Image size 2352x1568.
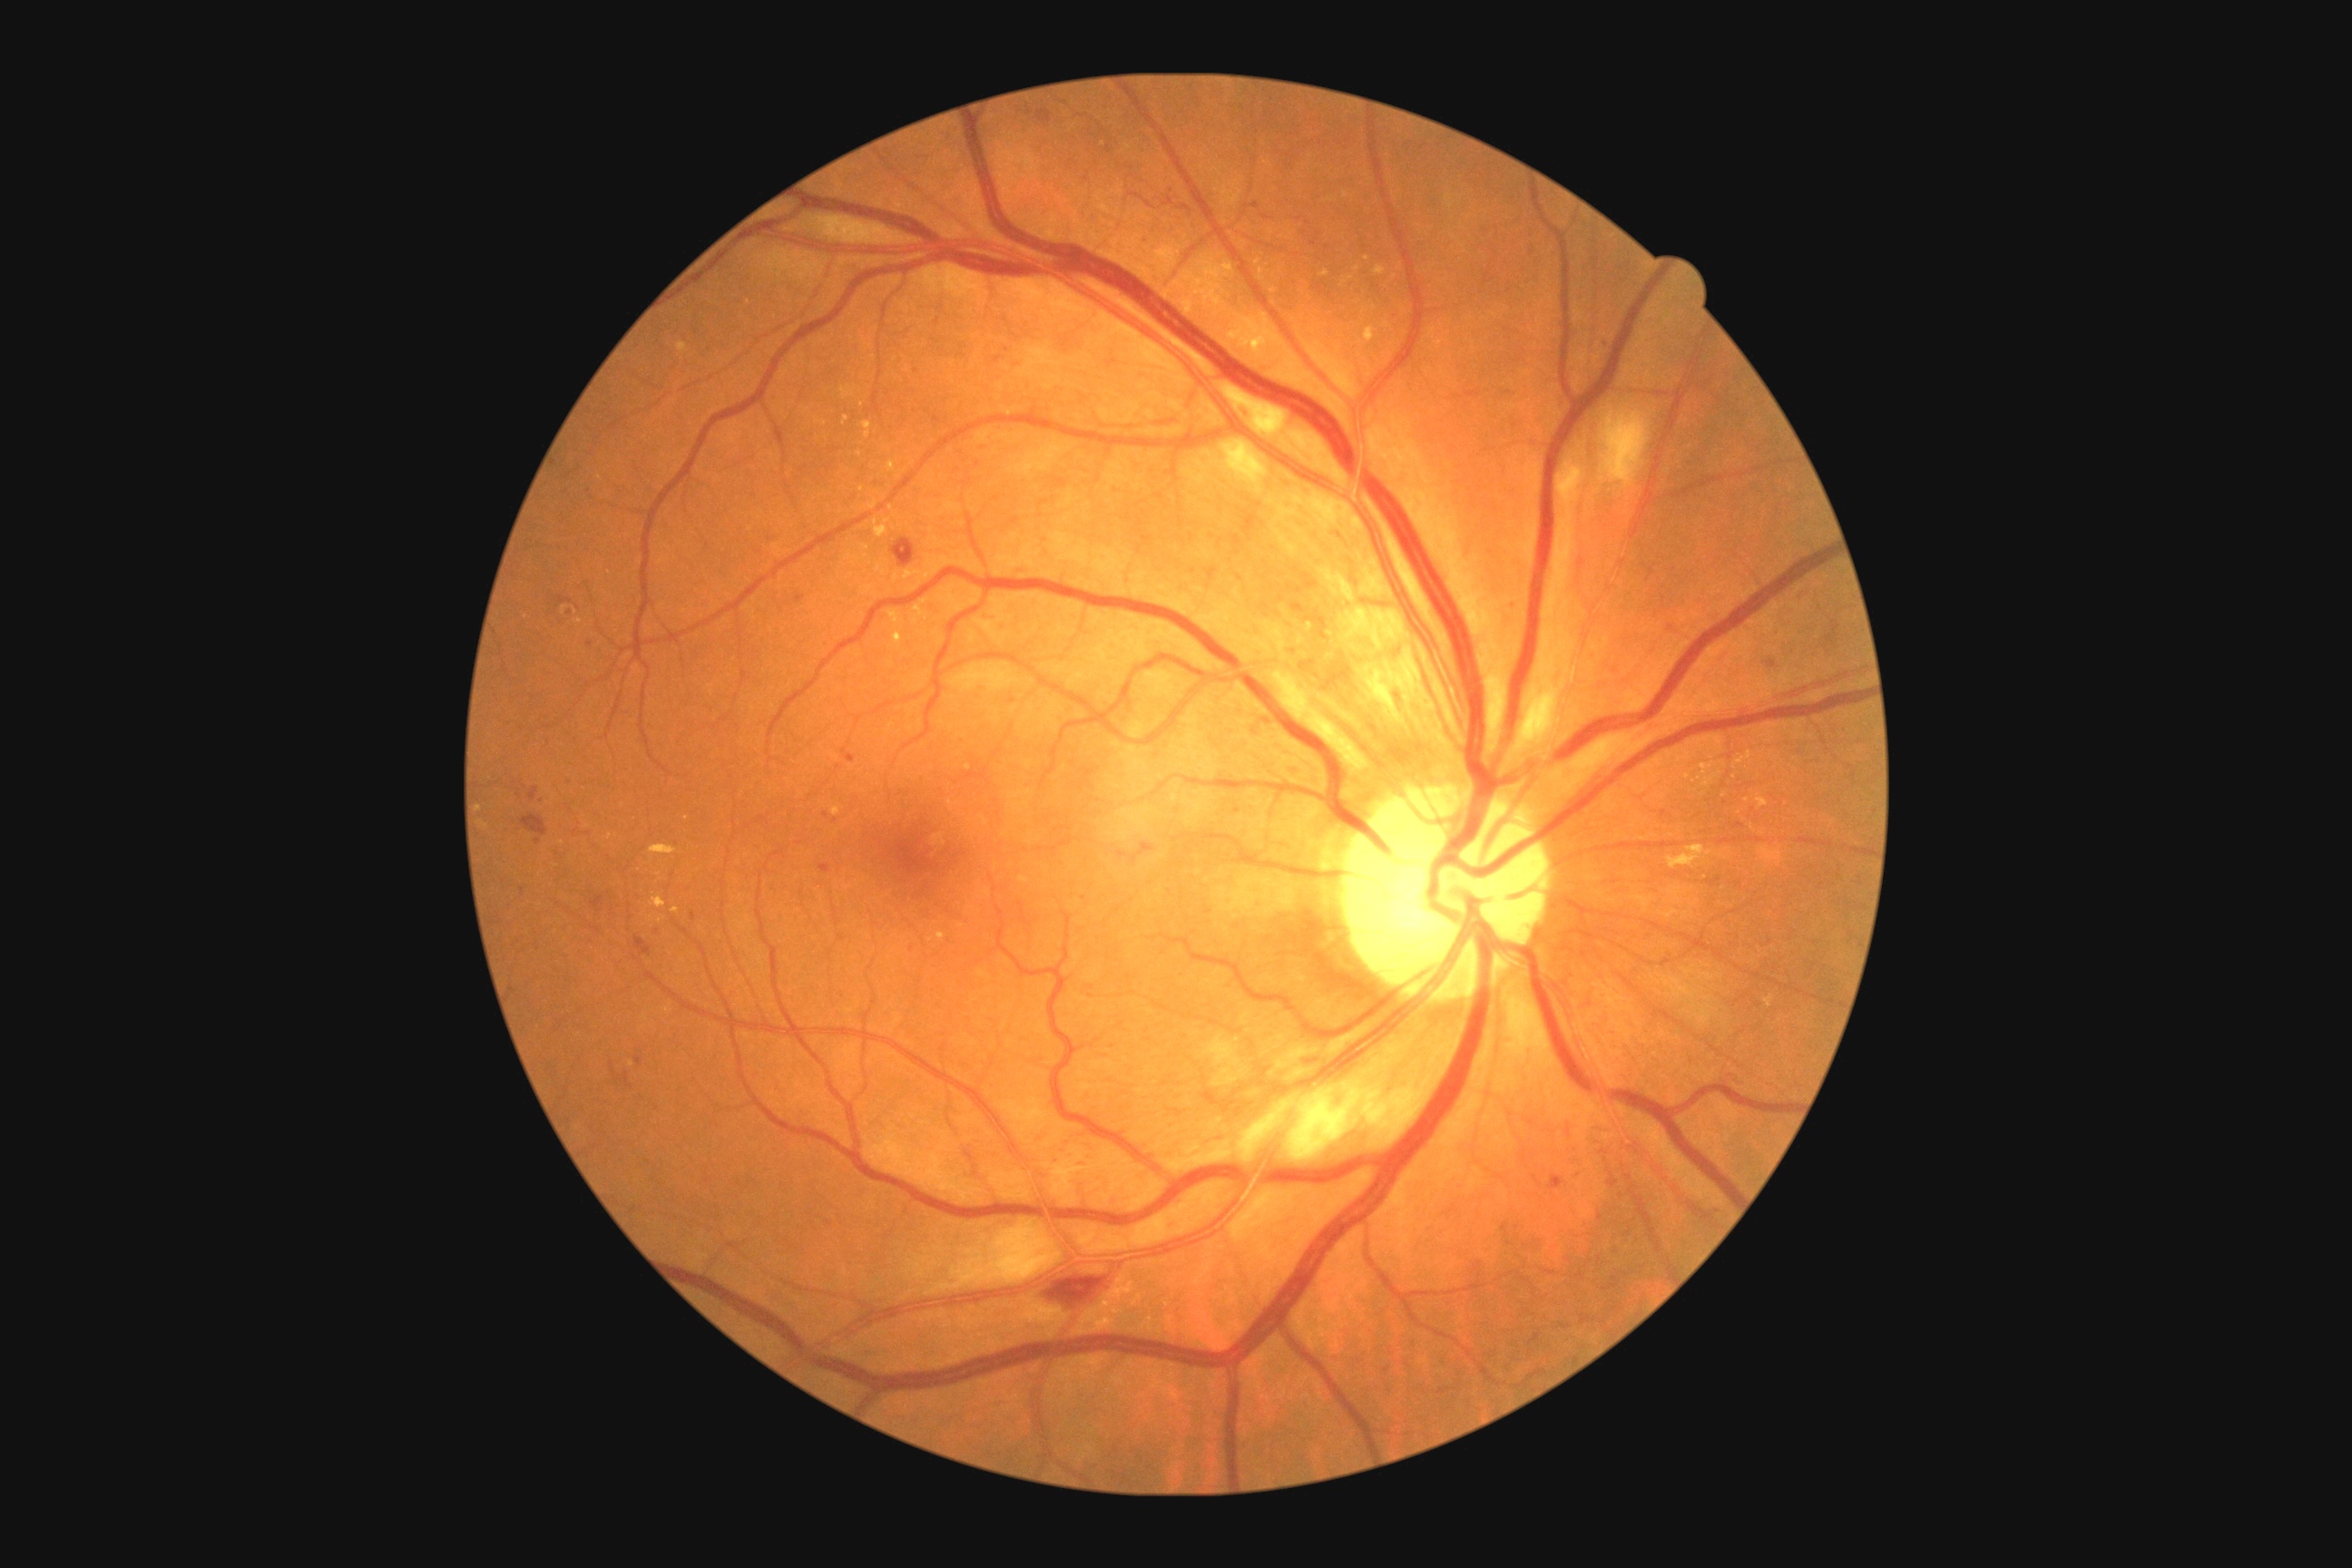 Diabetic retinopathy (DR): 2.